Captured with the Phoenix ICON (100° field of view) · 1240x1240px · pediatric wide-field fundus photograph
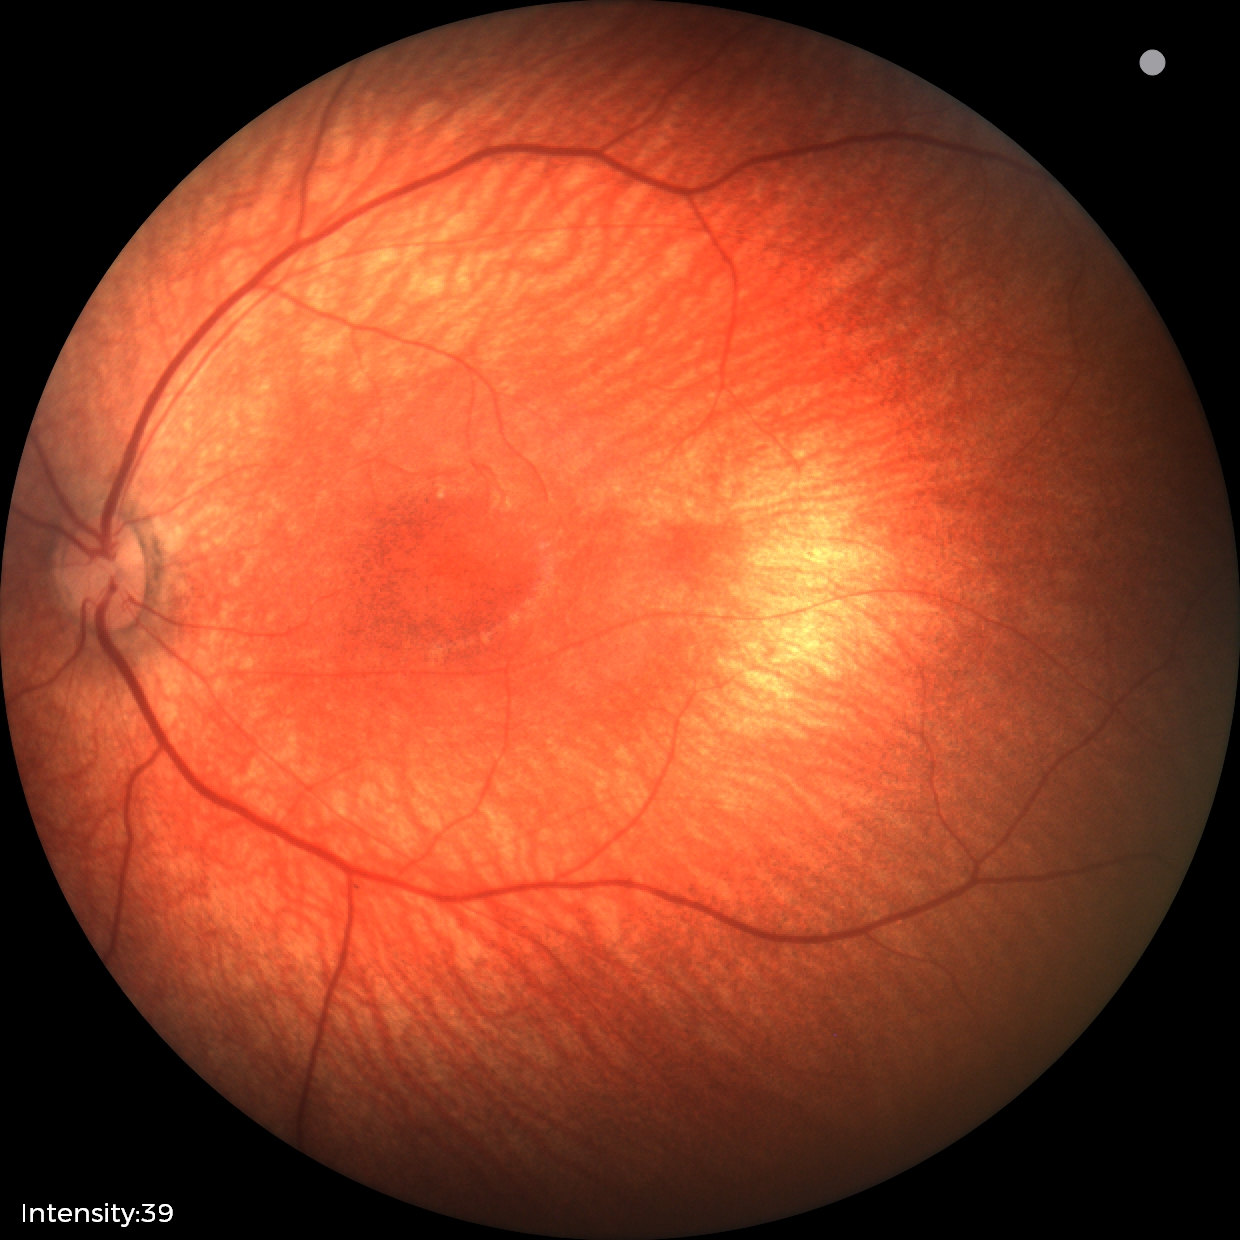 Screening examination consistent with retinal hemorrhages.